2102x1736 — 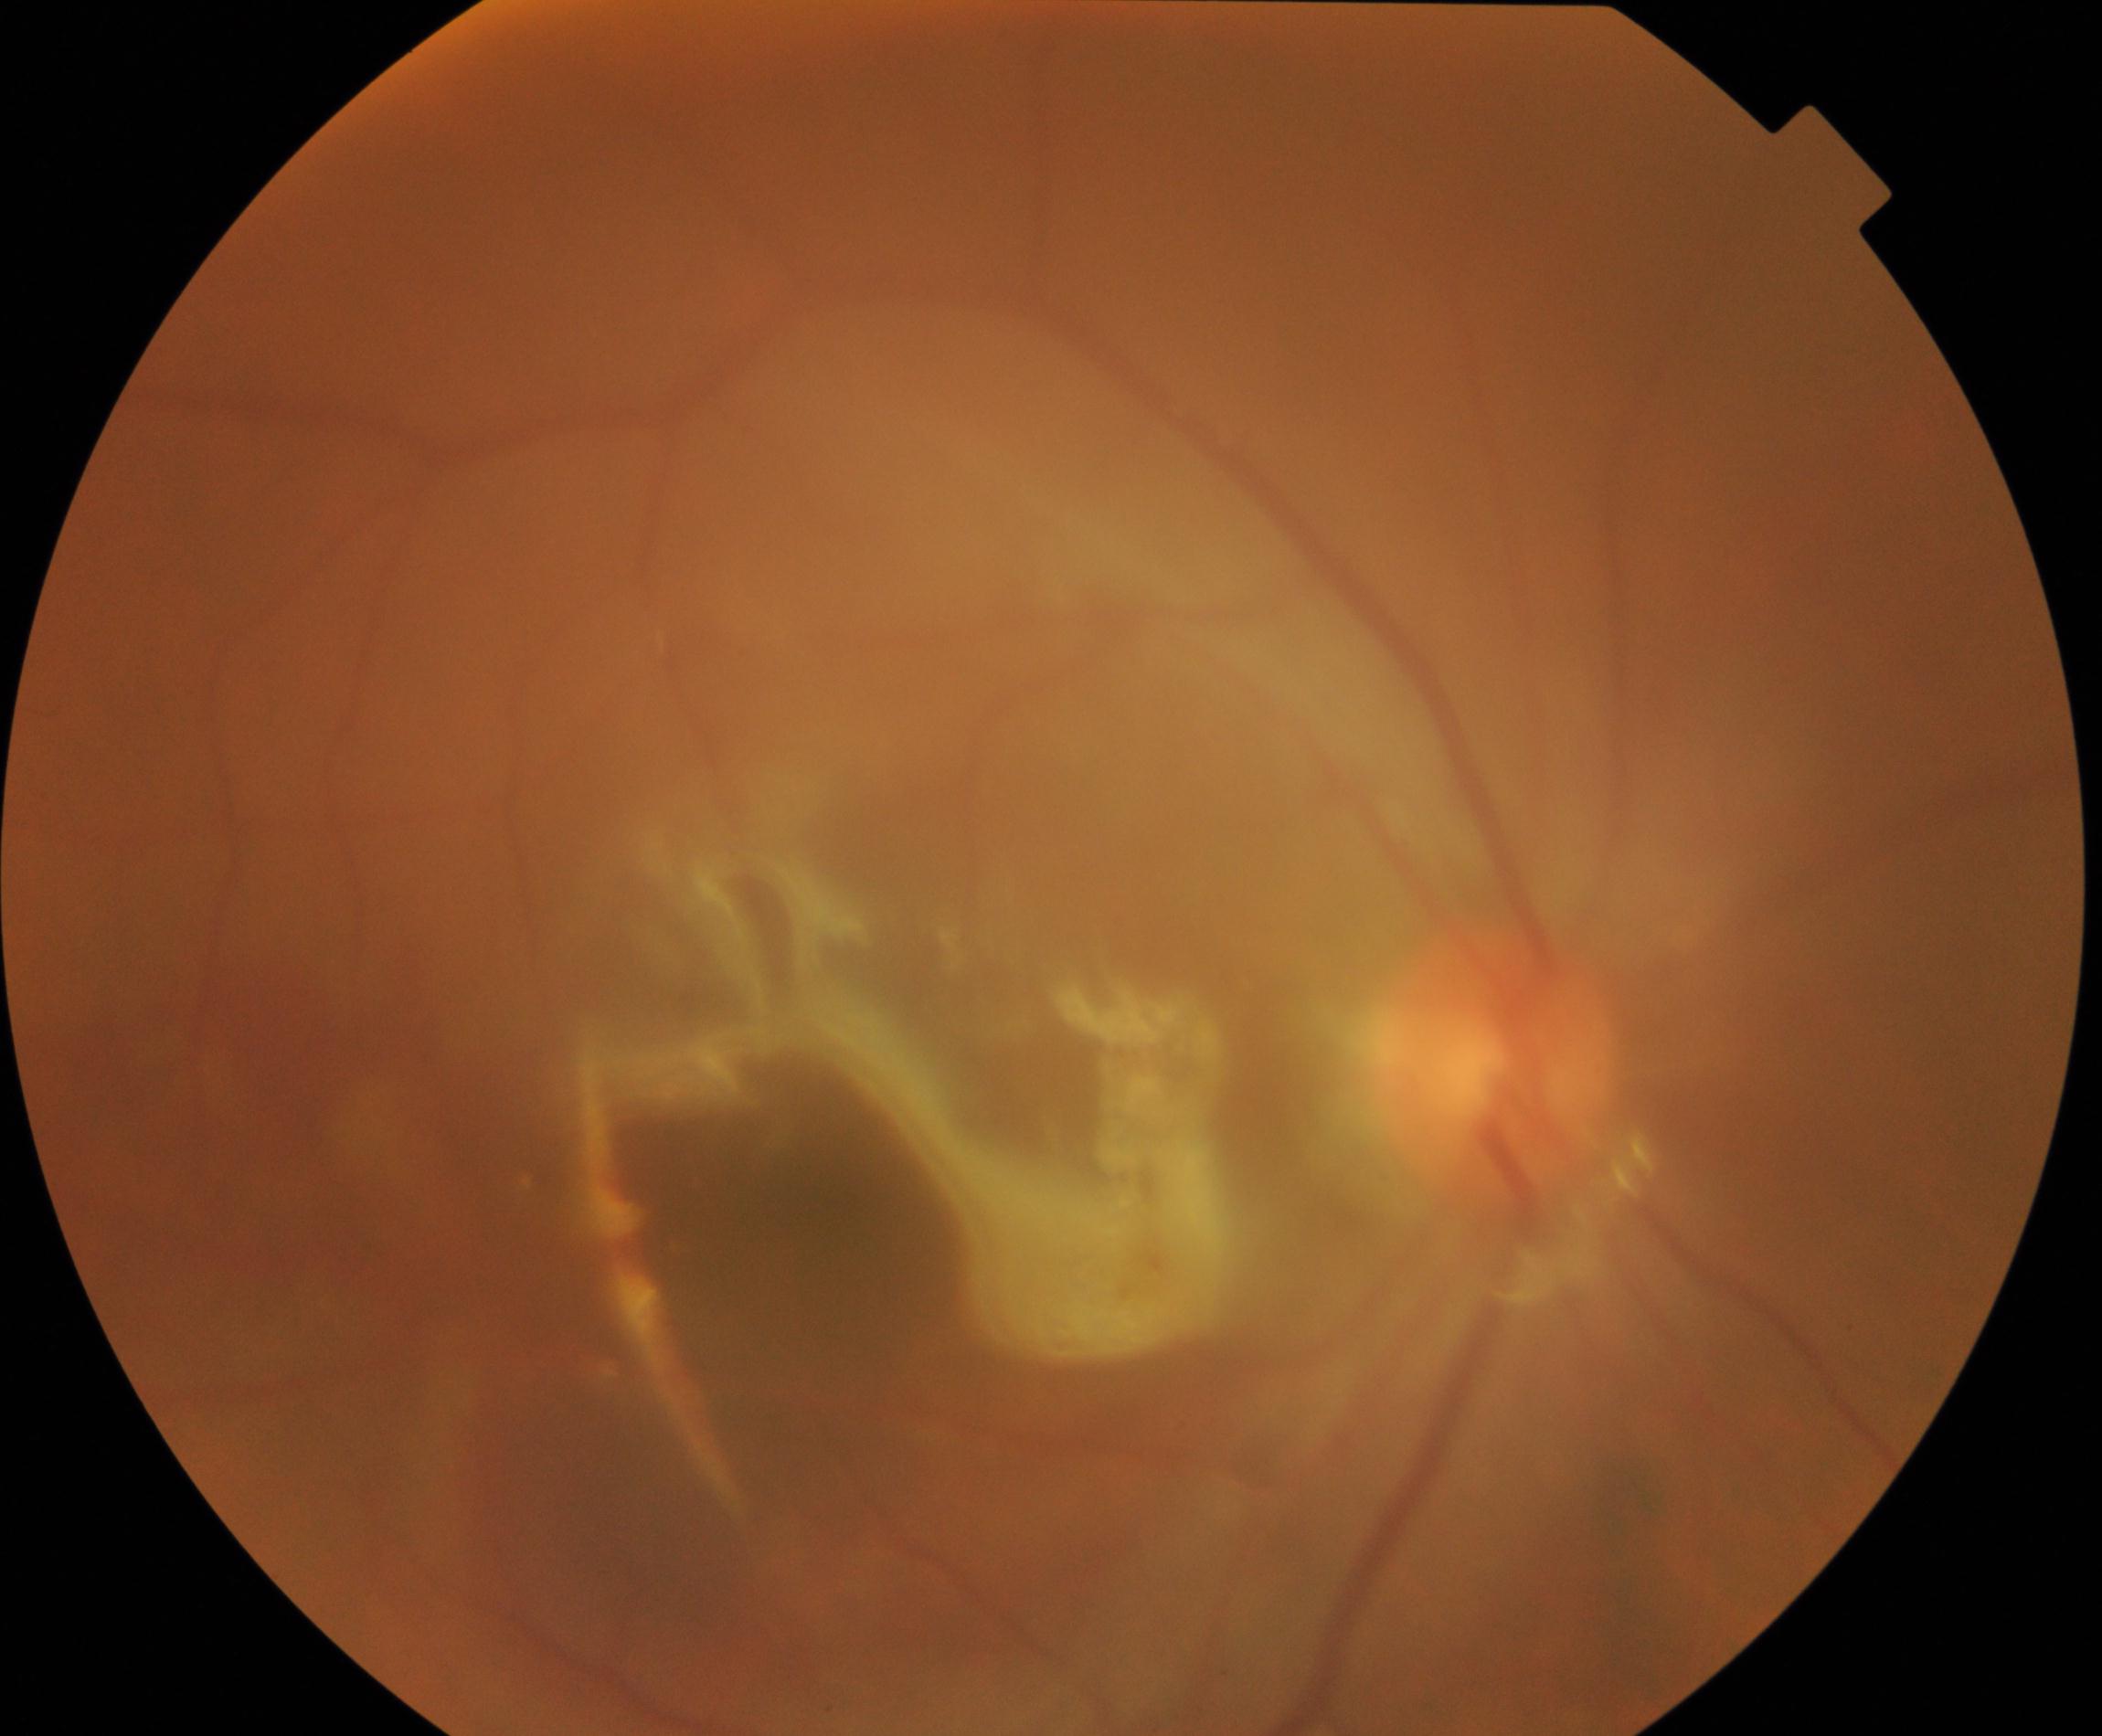
Impression: silicone oil in the eye.